Retinal fundus photograph:
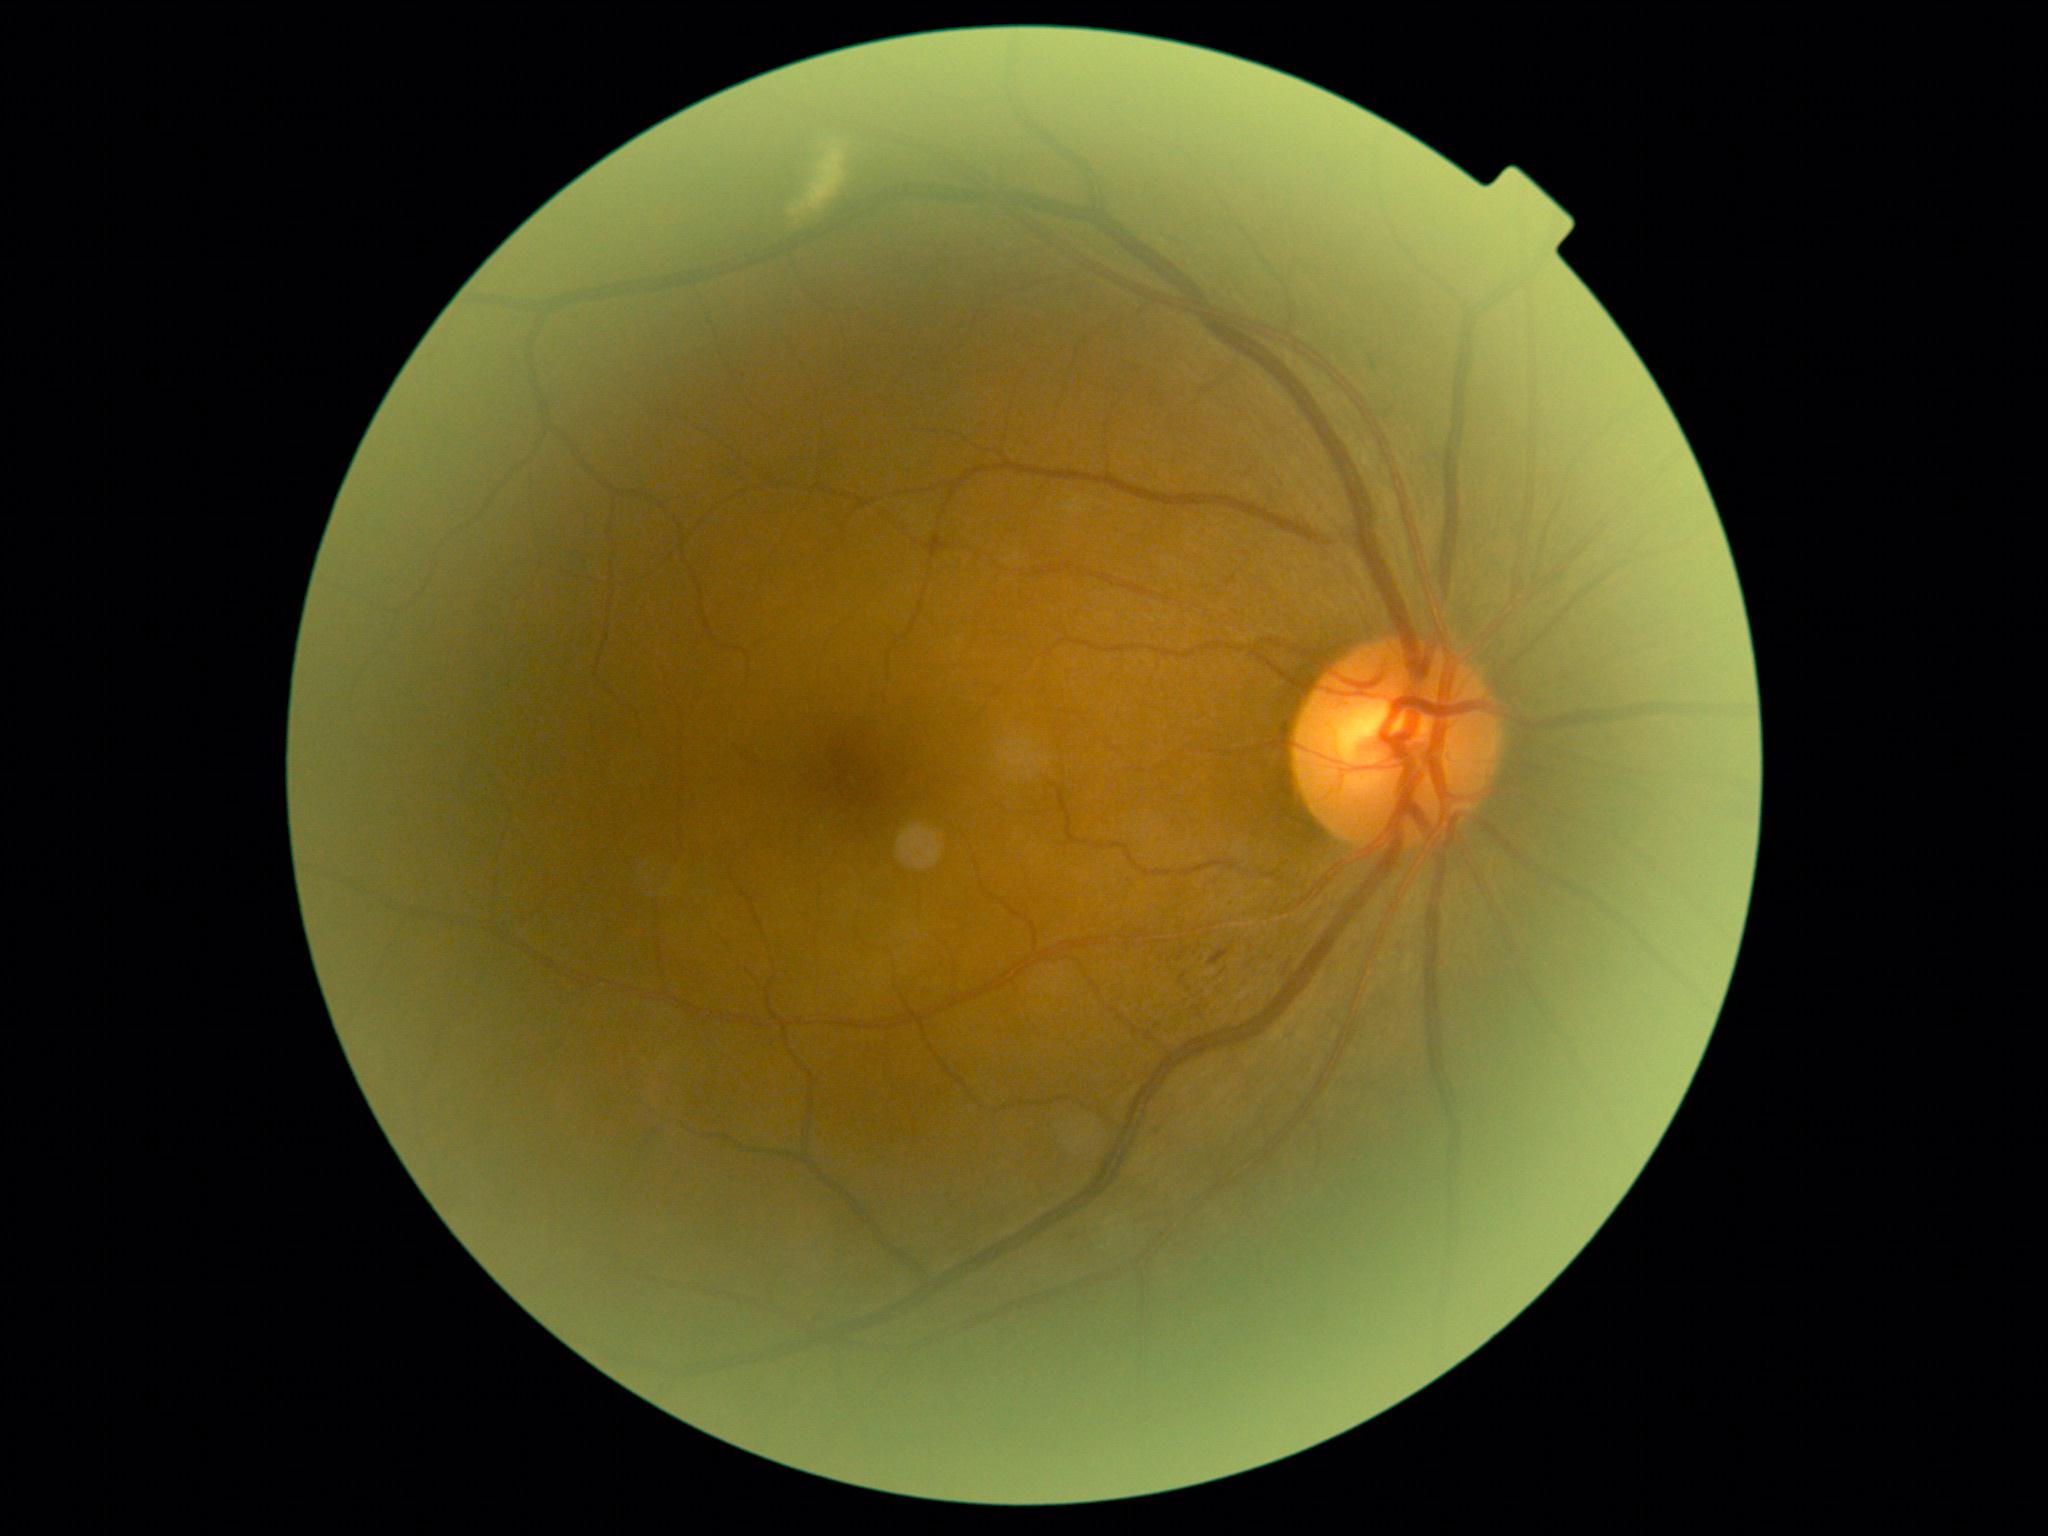

Retinopathy: grade 2 (moderate NPDR) — more than just microaneurysms but less than severe NPDR.